Nonmydriatic, 45 degree fundus photograph, color fundus image — 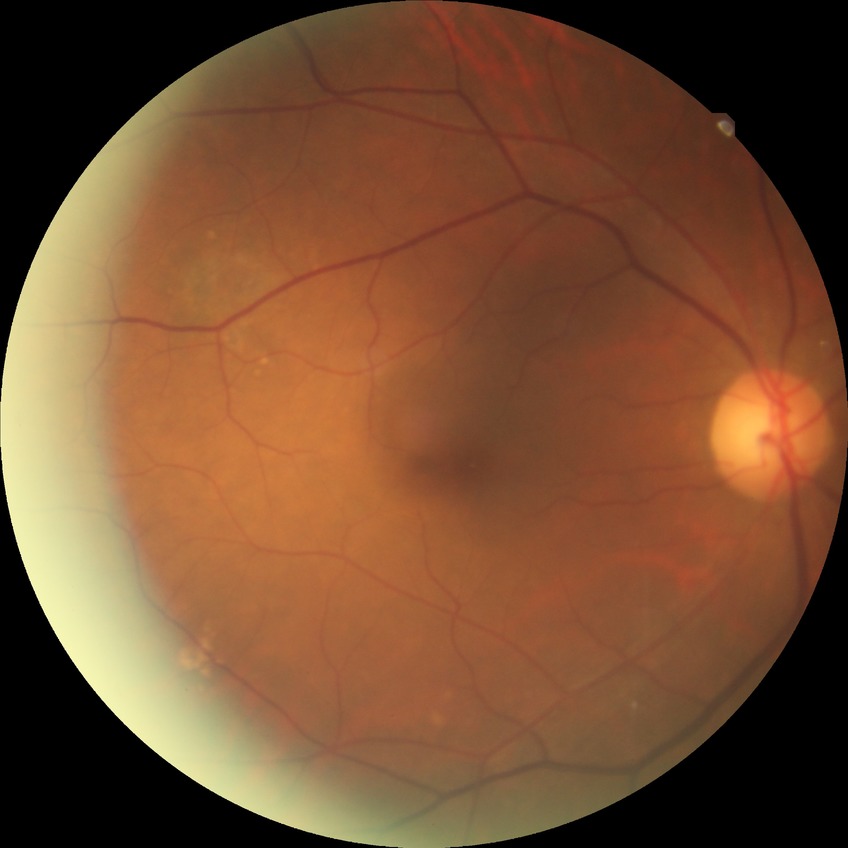
Diabetic retinopathy (DR) is no diabetic retinopathy (NDR).